CFP: 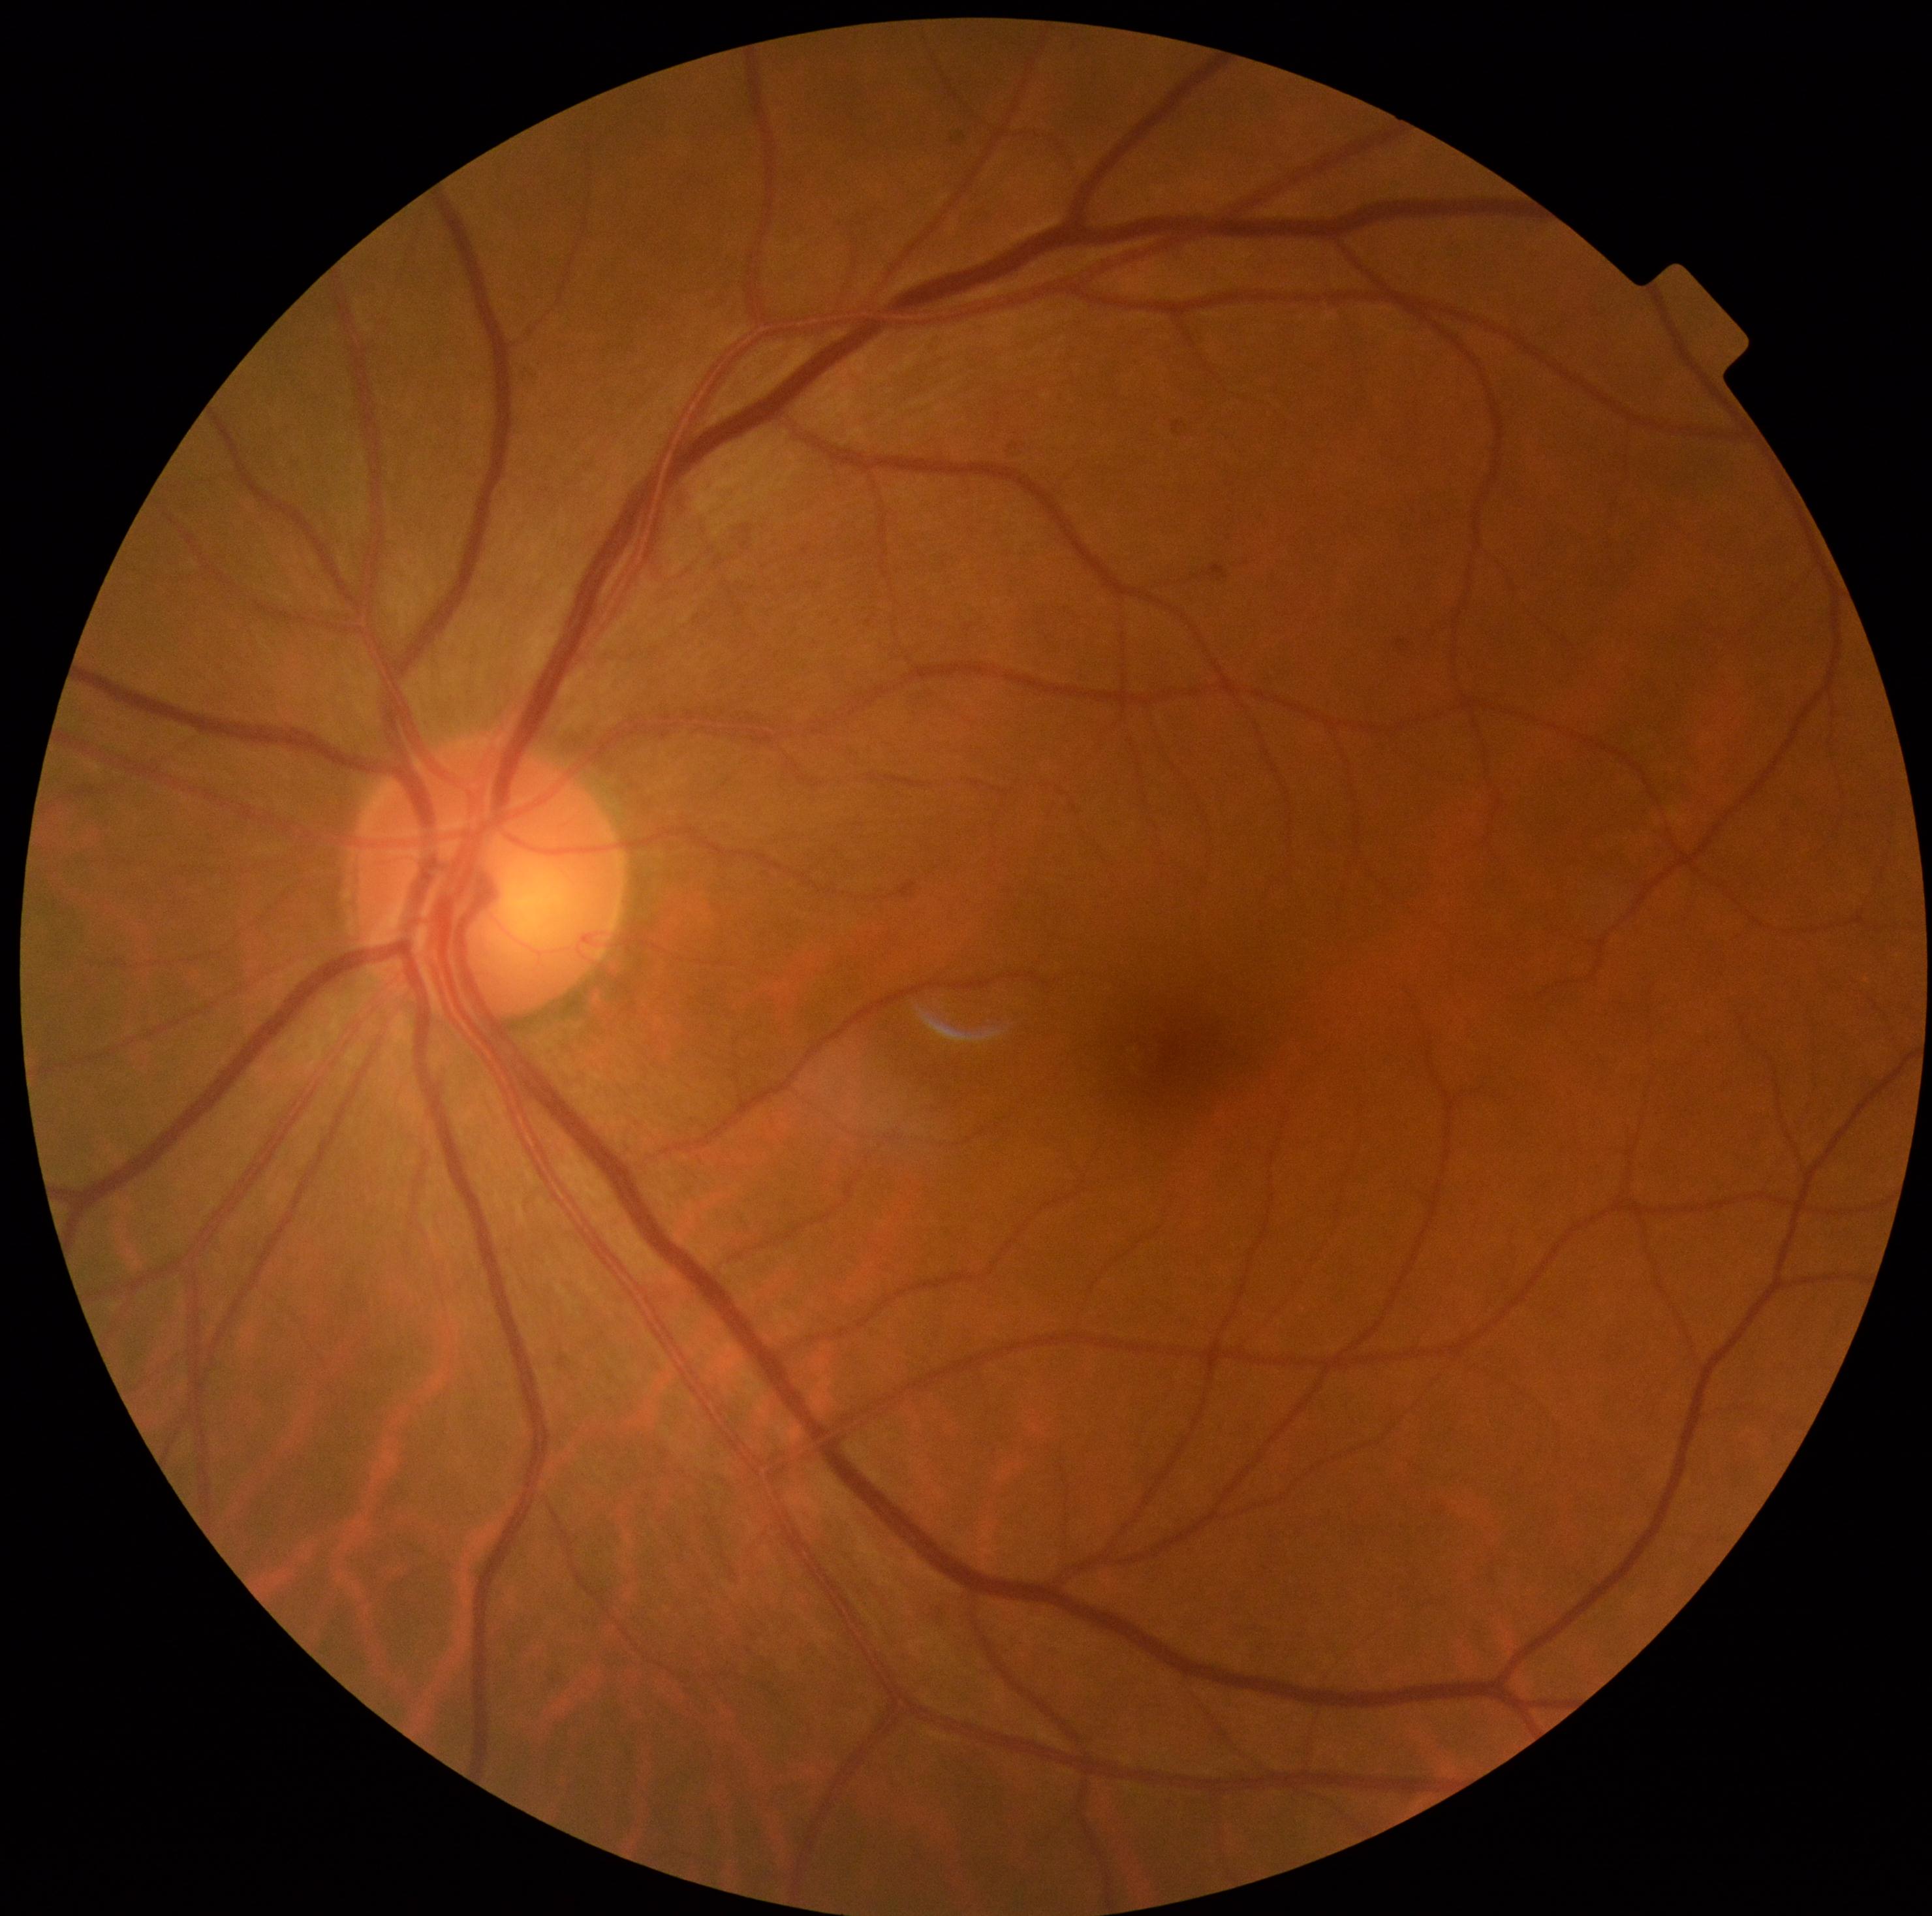

diabetic retinopathy severity@no apparent retinopathy (grade 0).